Color fundus photograph; image size 2212x1659; 45-degree field of view — 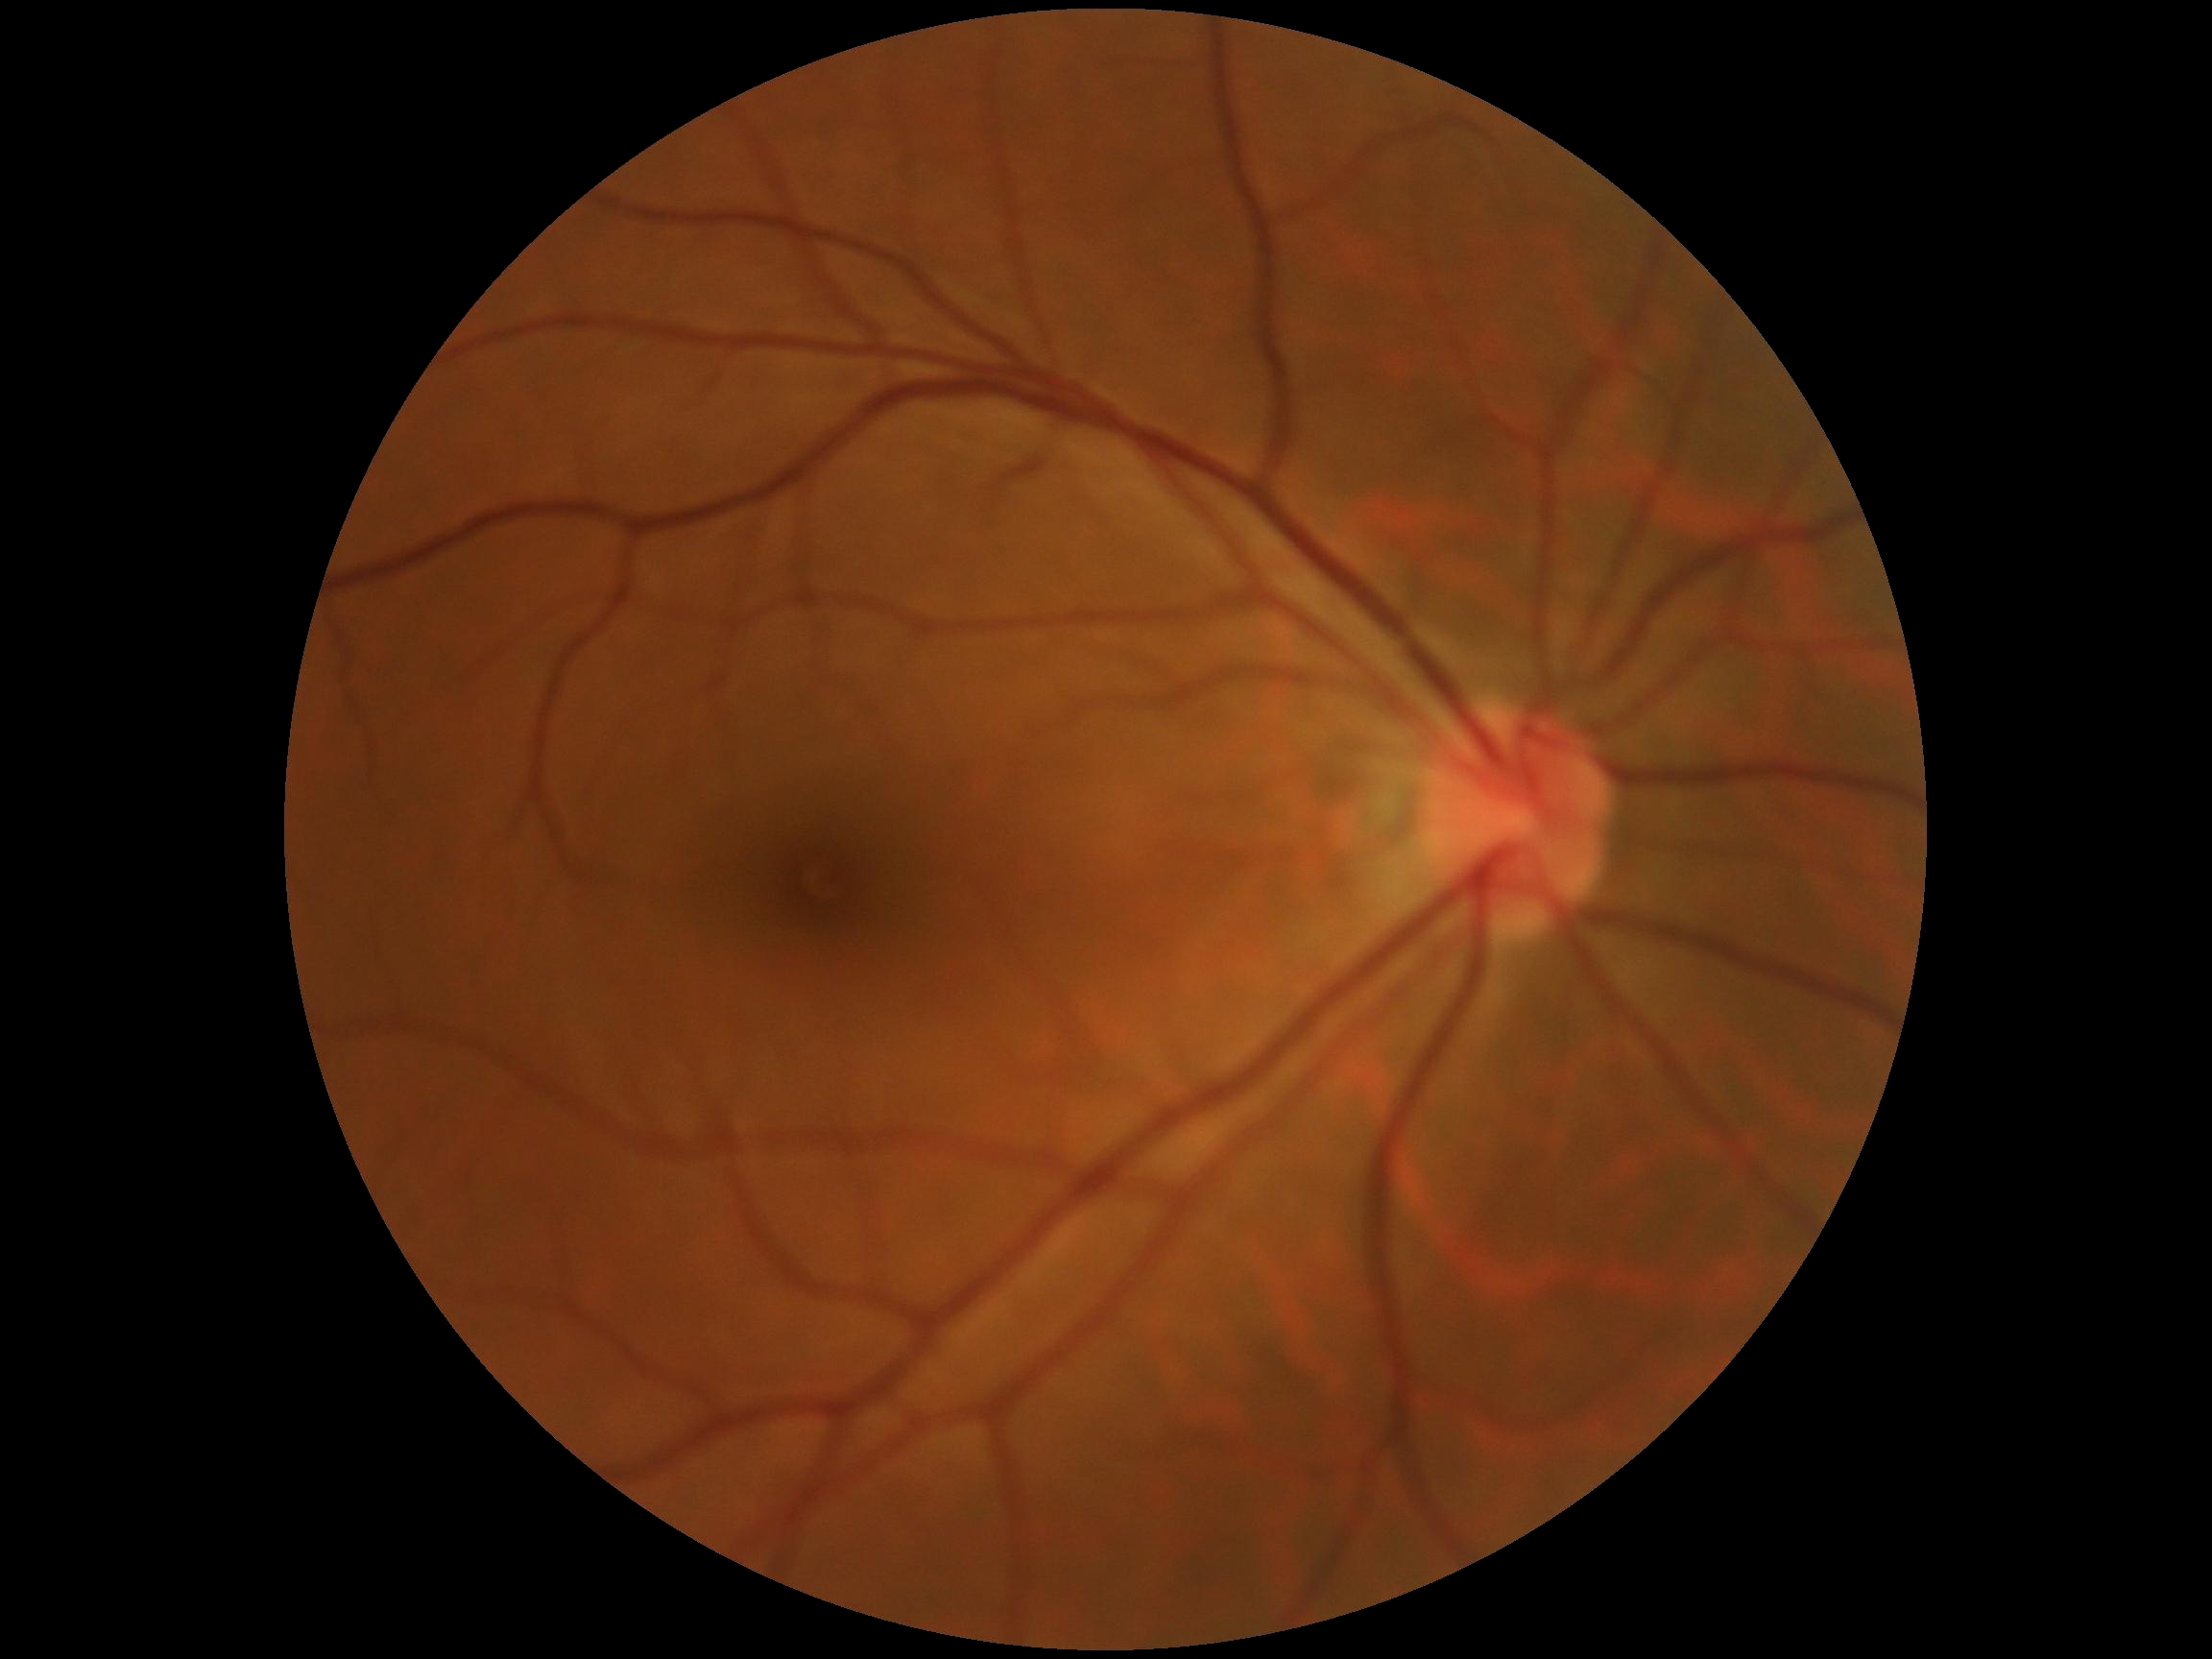
Retinopathy: no apparent diabetic retinopathy (grade 0). No signs of diabetic retinopathy.